1440x1080. 130° field of view (Natus RetCam Envision). Infant wide-field fundus photograph.
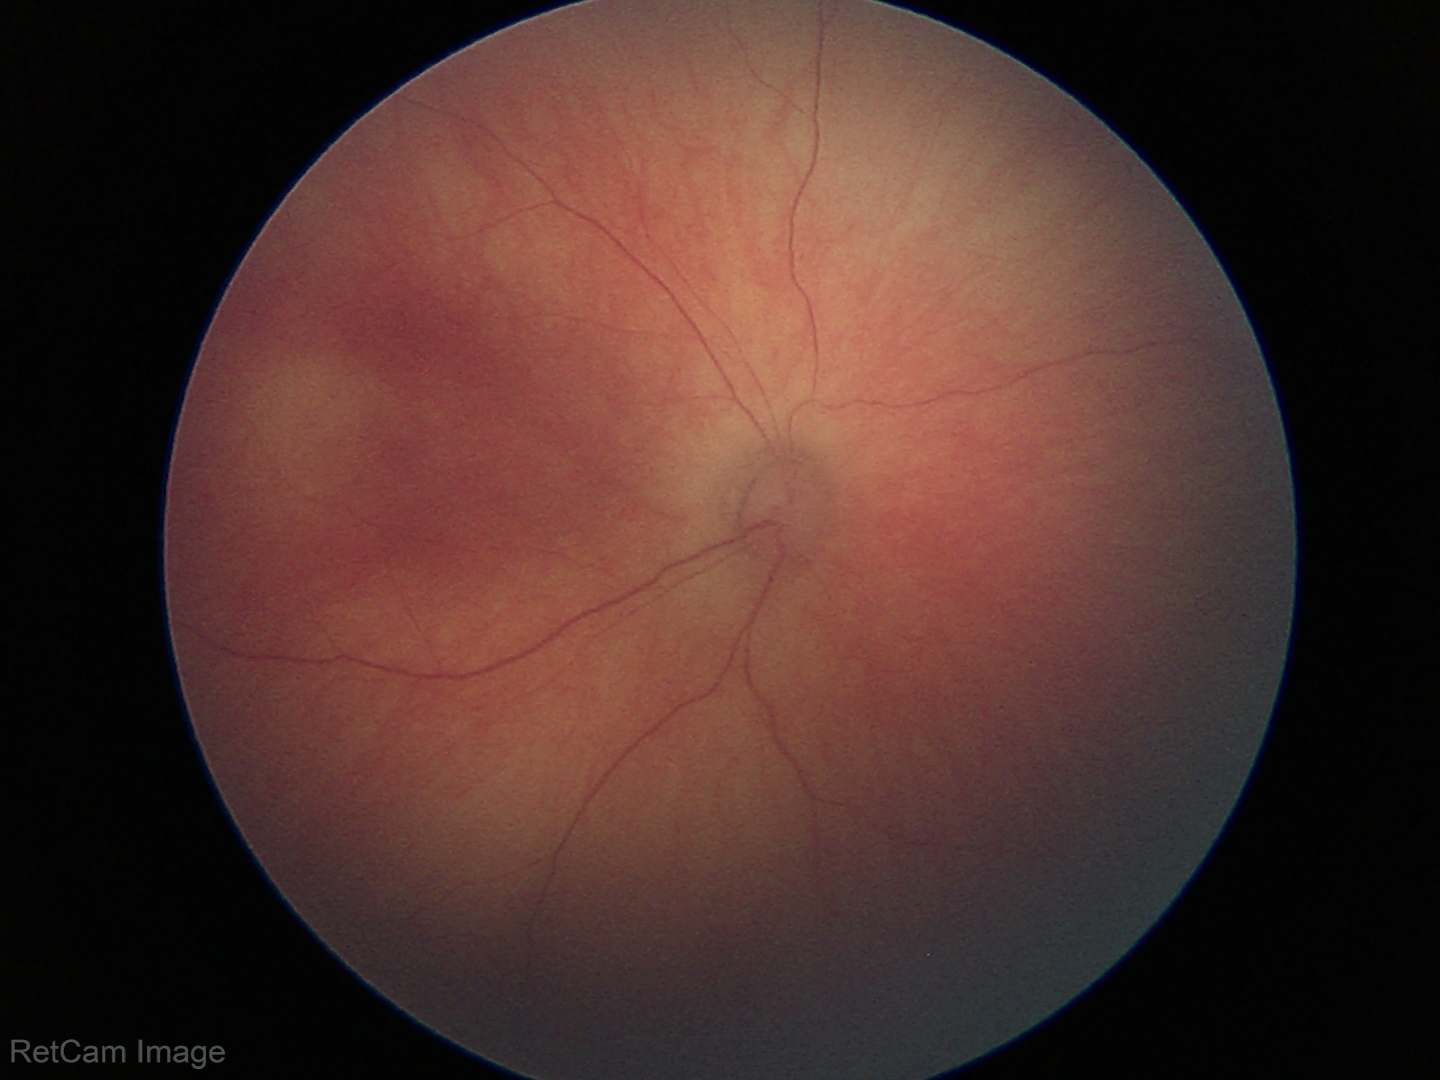 Screening: physiological appearance with no retinal pathology.